848x848px:
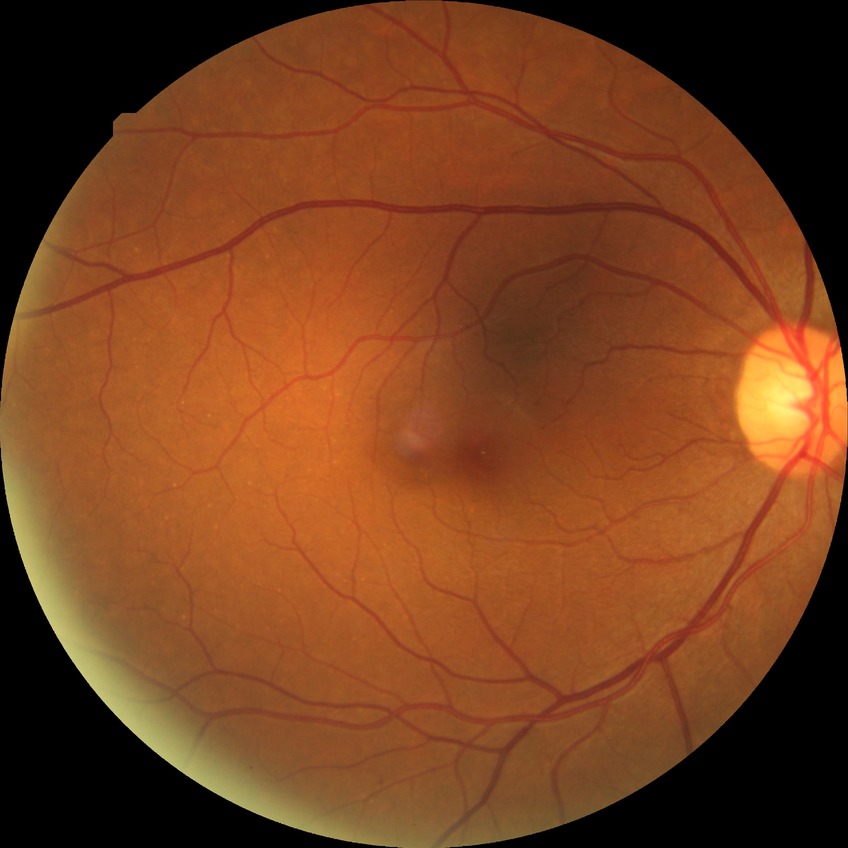 Davis grading: simple diabetic retinopathy.